Image size 640x480. Pediatric wide-field fundus photograph — 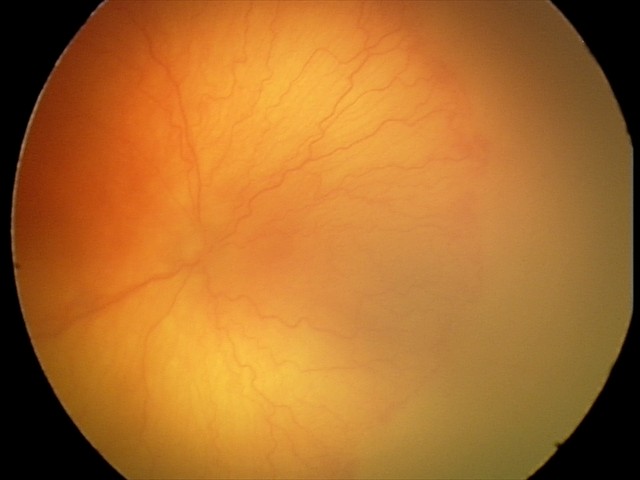
Examination diagnosed as aggressive ROP (A-ROP). Plus disease present.